Pediatric retinal photograph (wide-field).
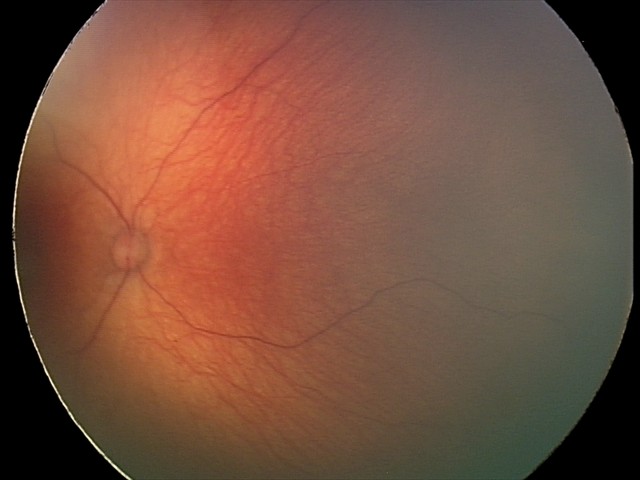

Screening examination diagnosed as physiological.